848 by 848 pixels; no pharmacologic dilation — 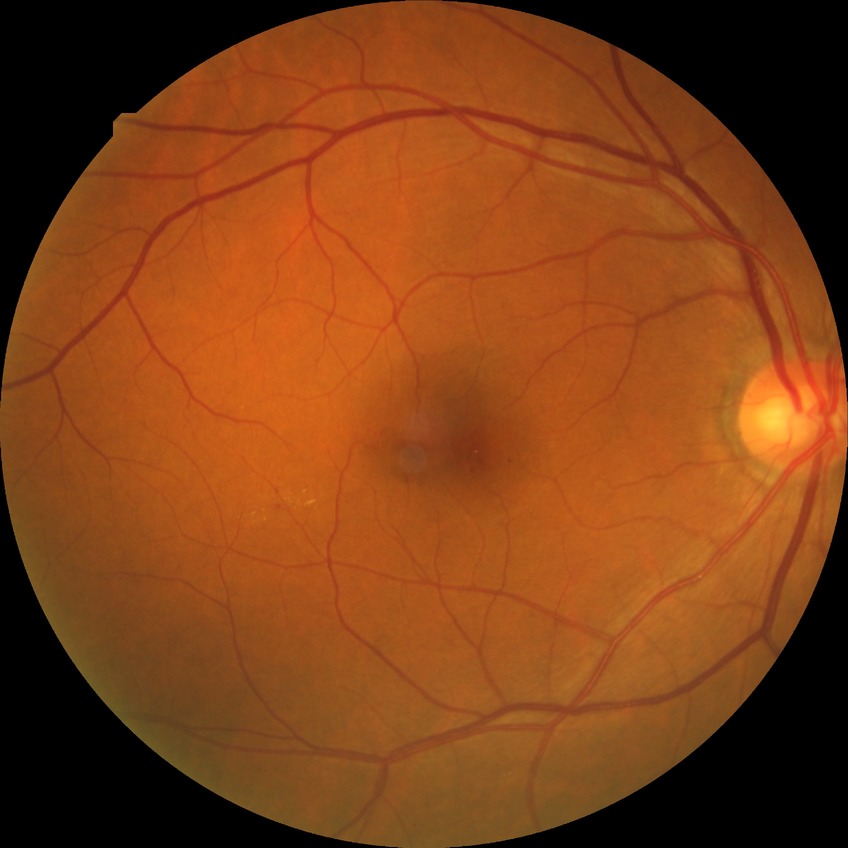 Diabetic retinopathy (DR) is simple diabetic retinopathy (SDR).